Color fundus image; 2102x1736 — 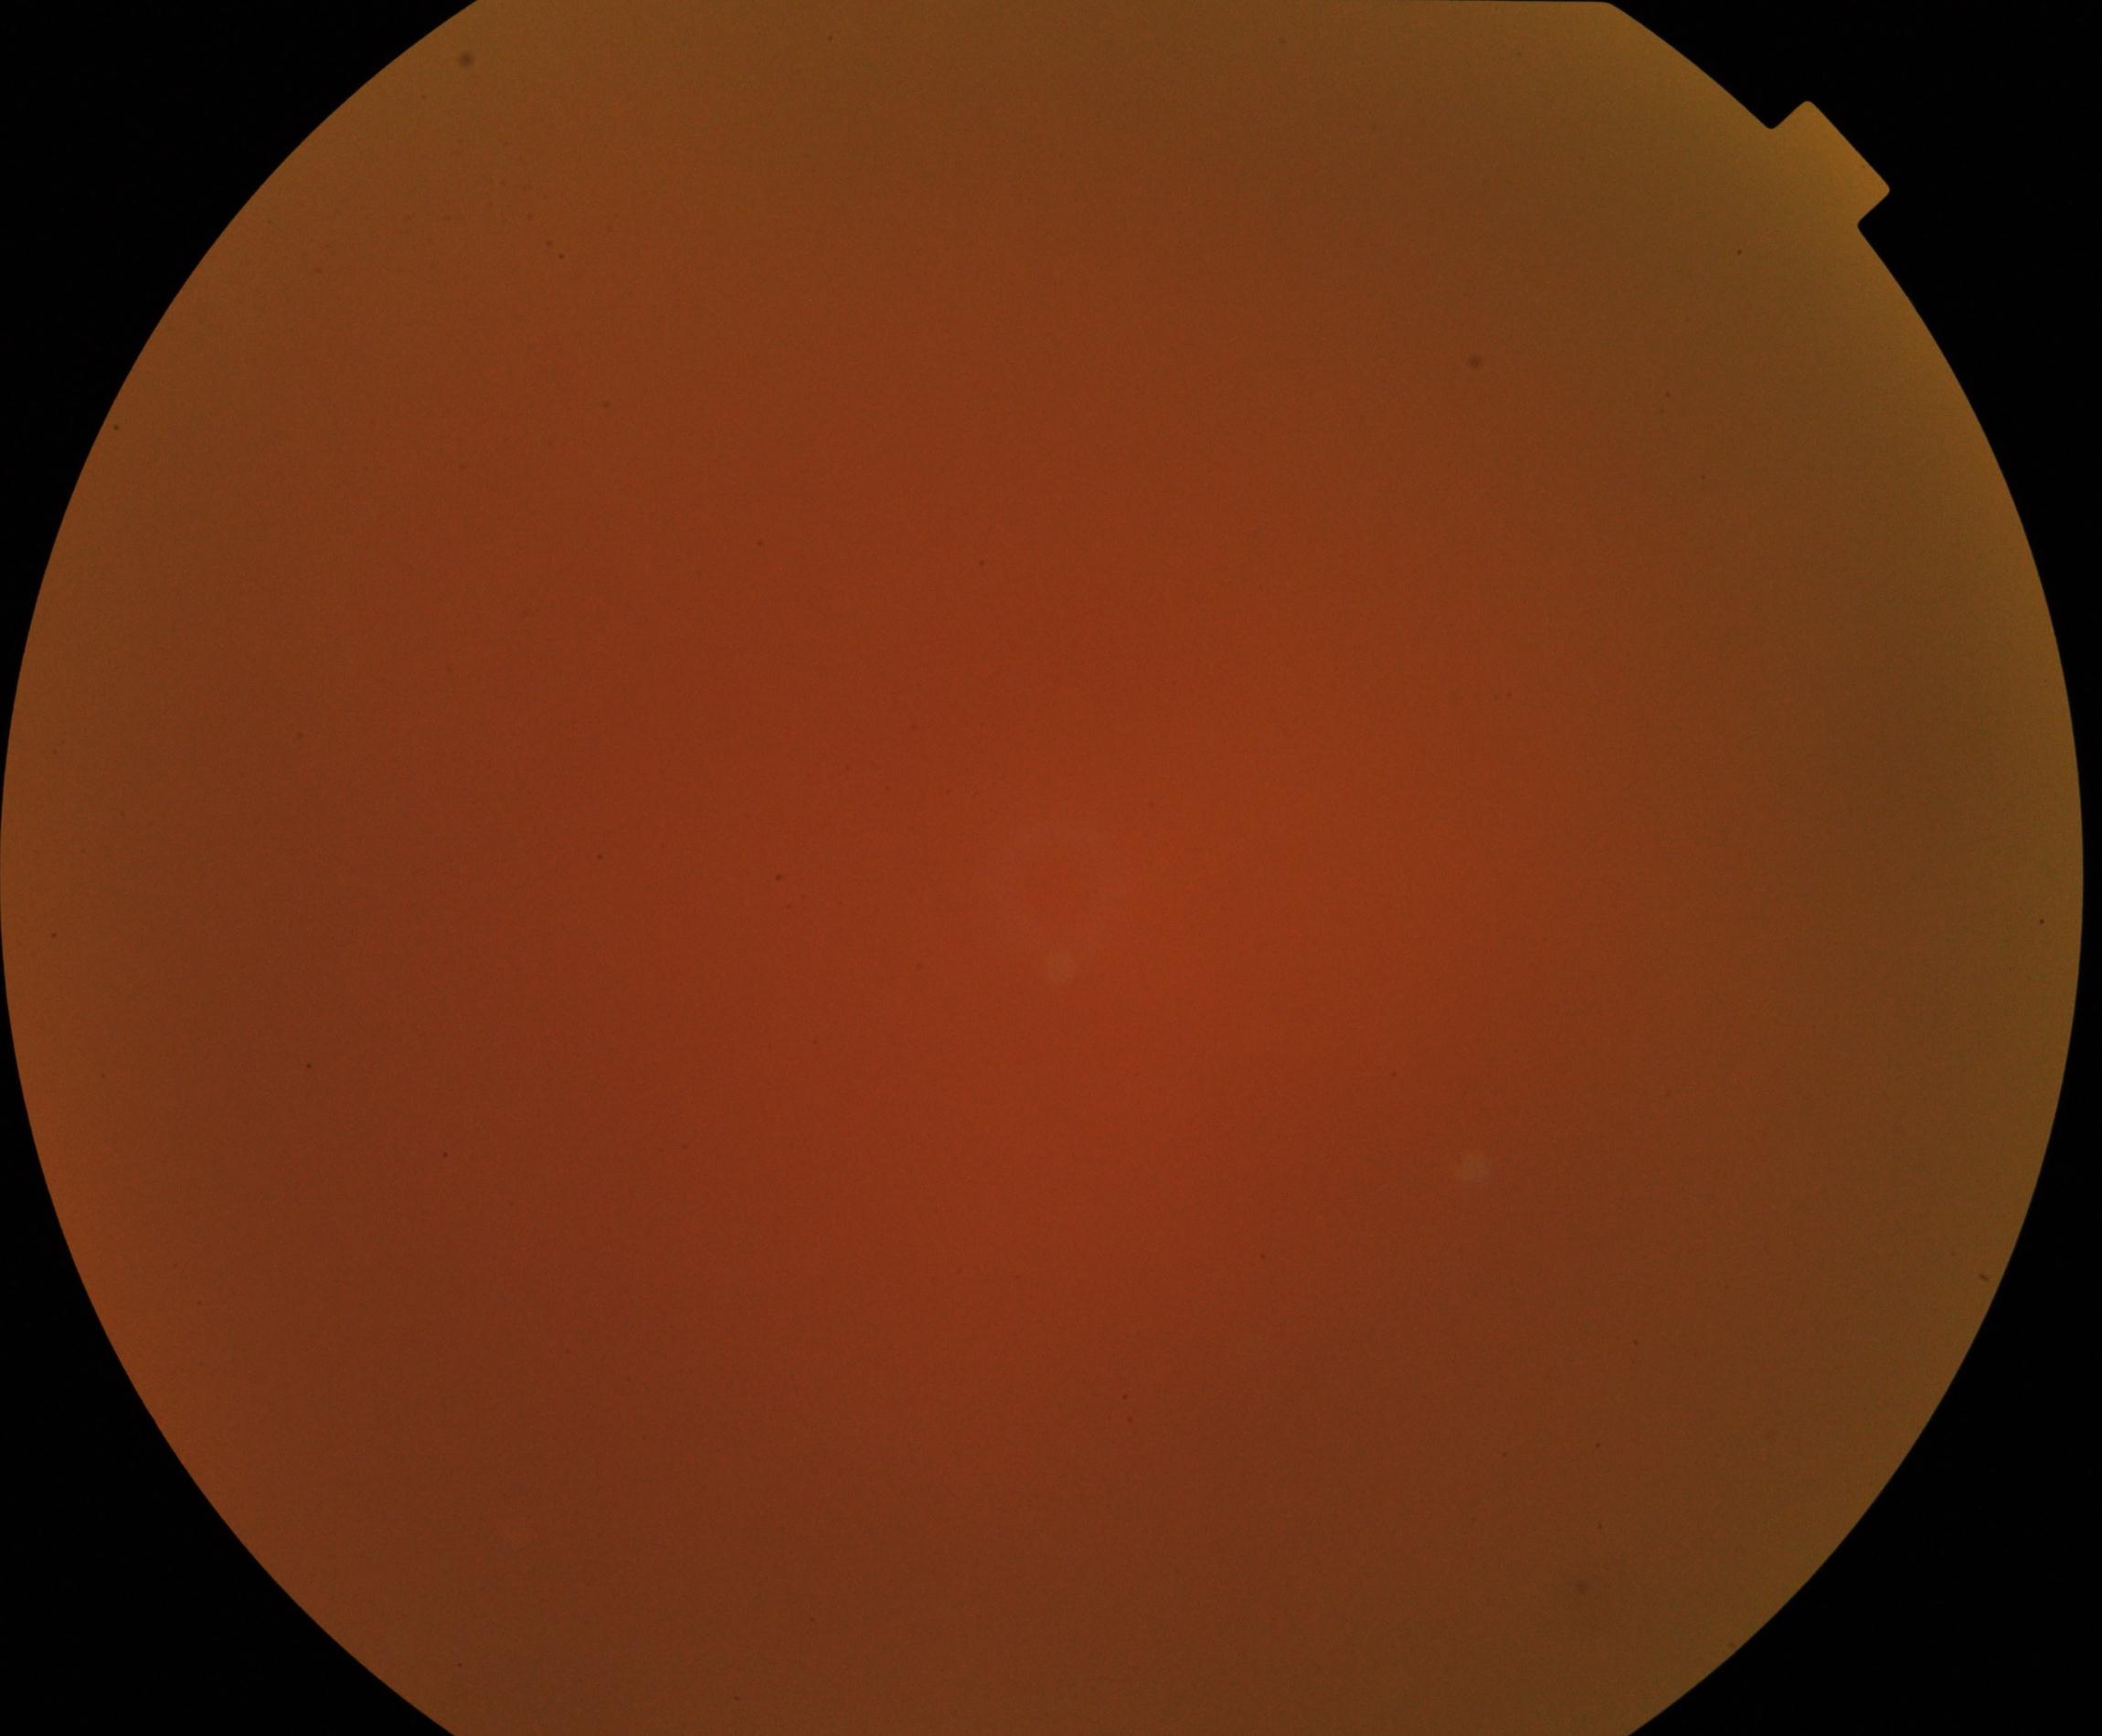

Image quality is poor; more than half the field is obscured. No evidence of proliferative diabetic retinopathy.